1932x1932, fundus photo, 50° FOV.
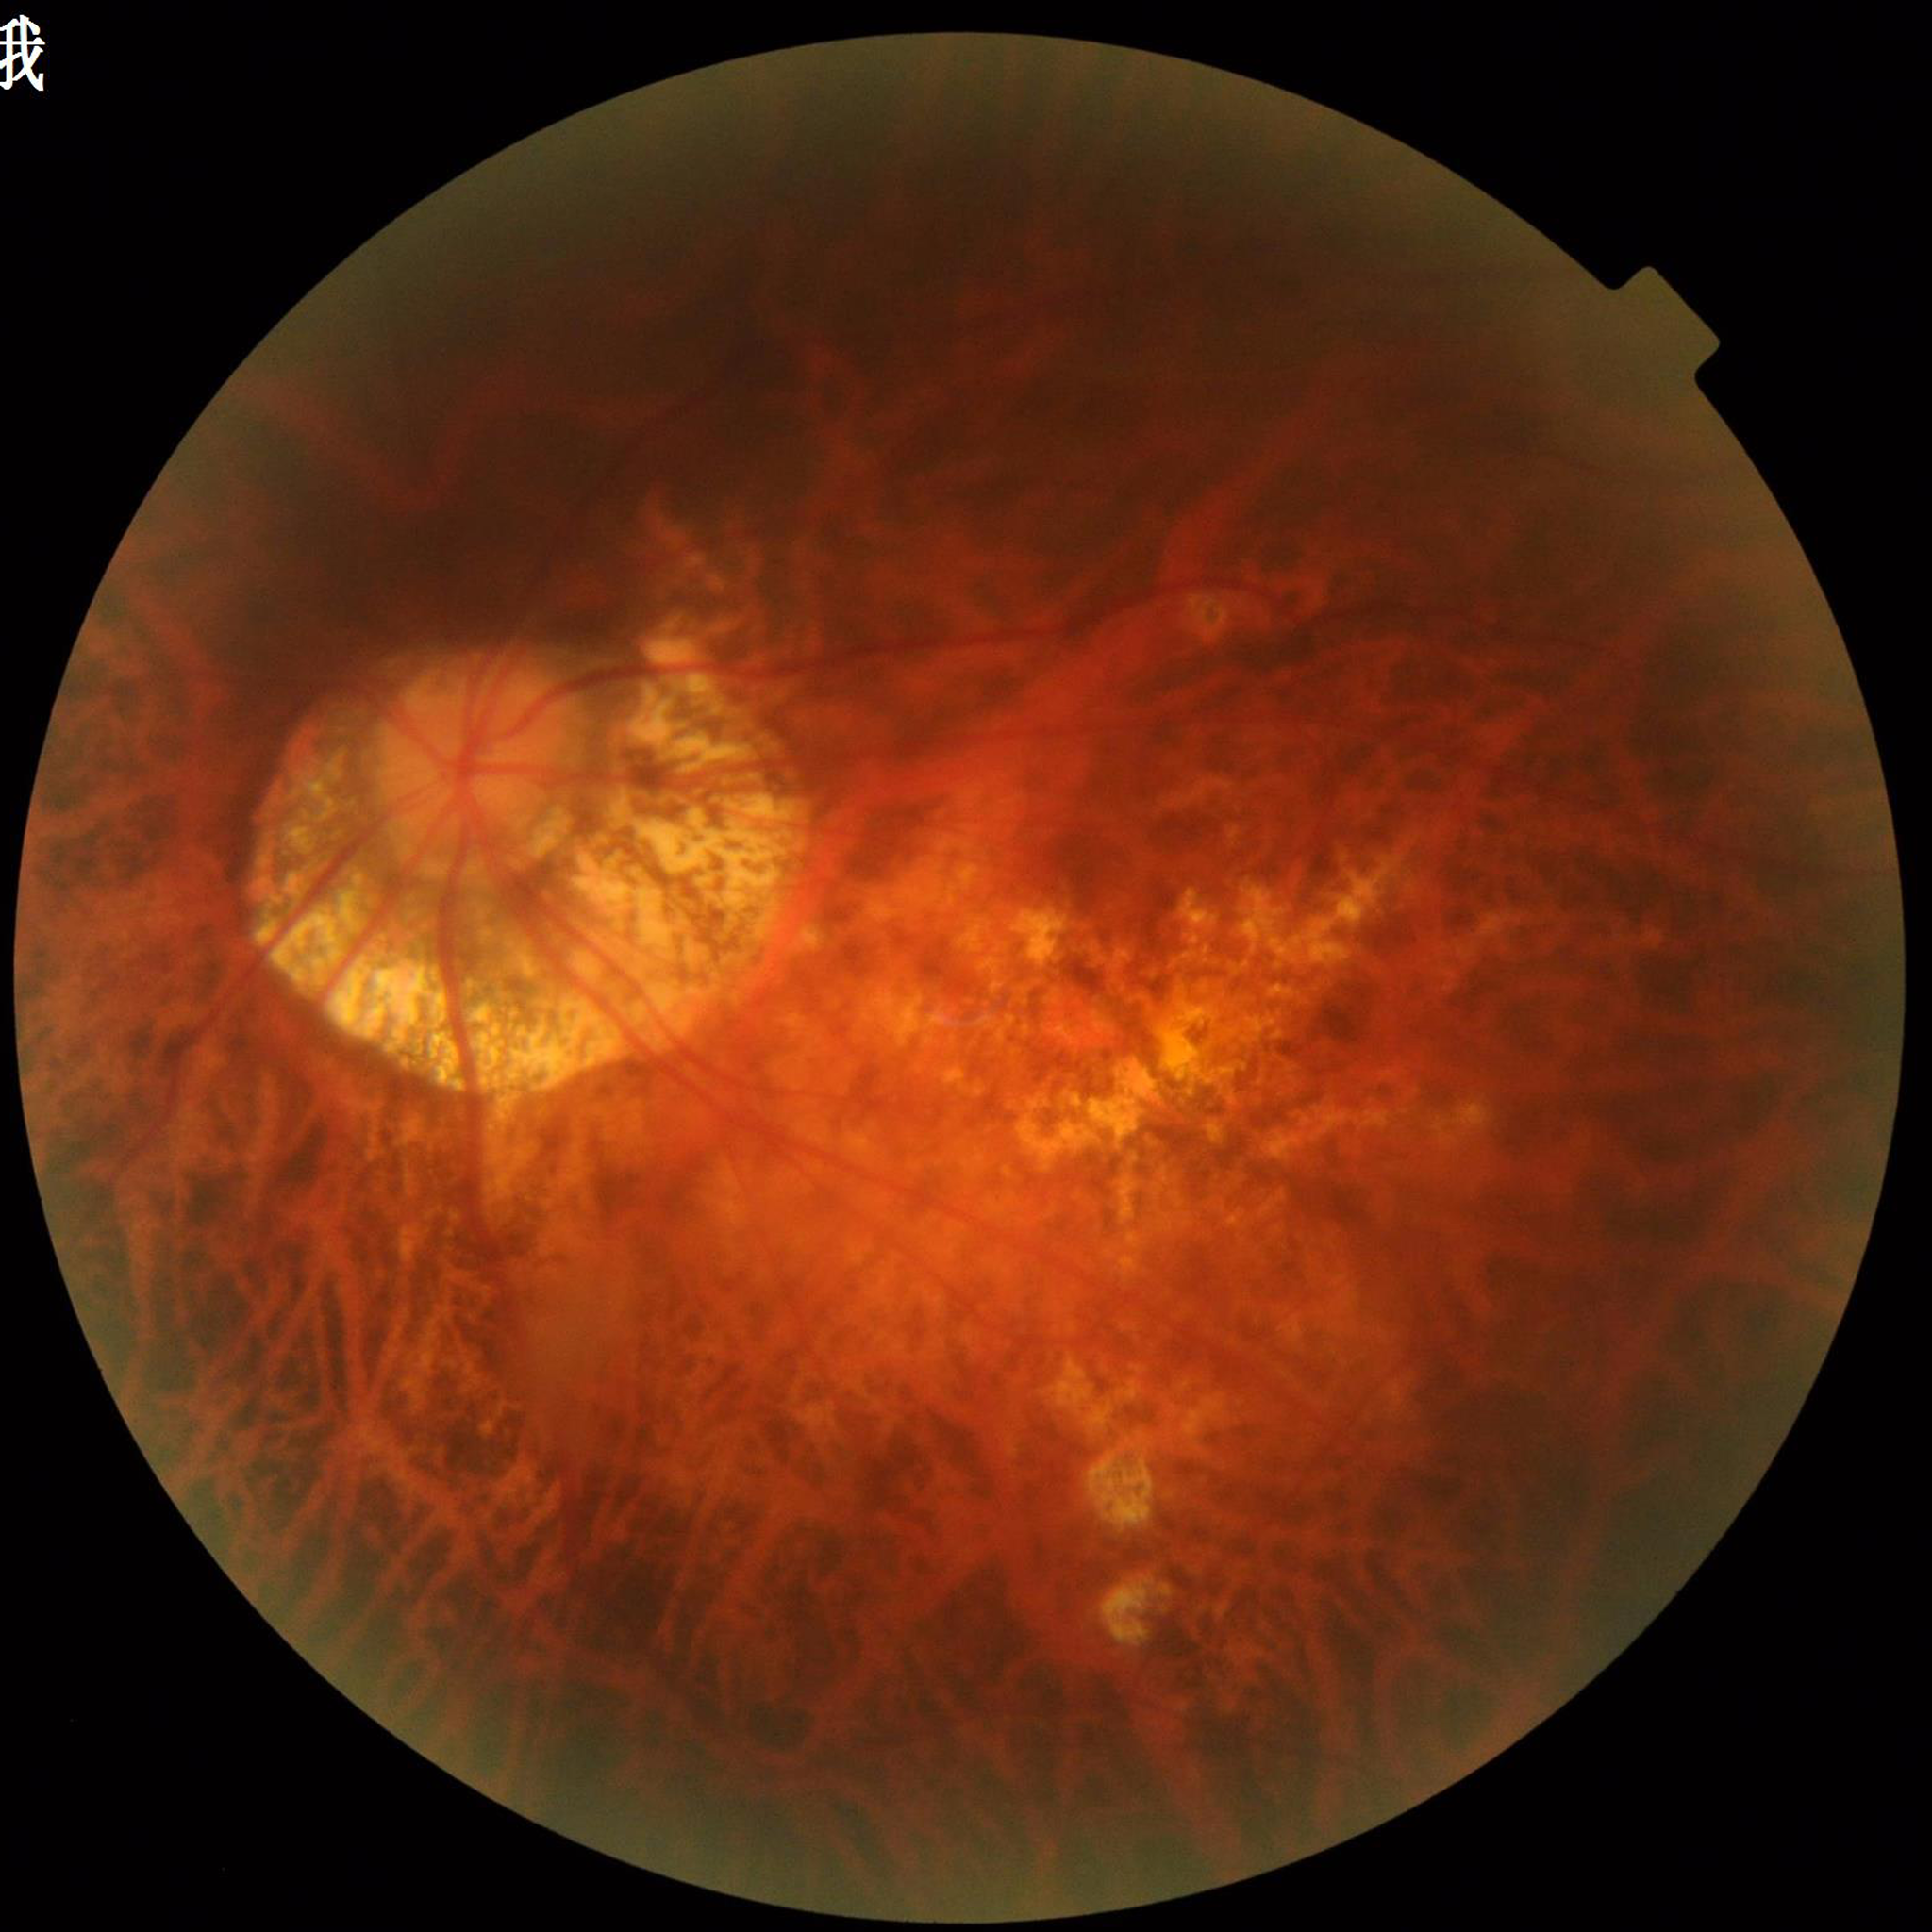

Eye affected by age-related macular degeneration.
Automated quality assessment: concerns include illumination/color distortion, blur.